Wide-field fundus photograph of an infant
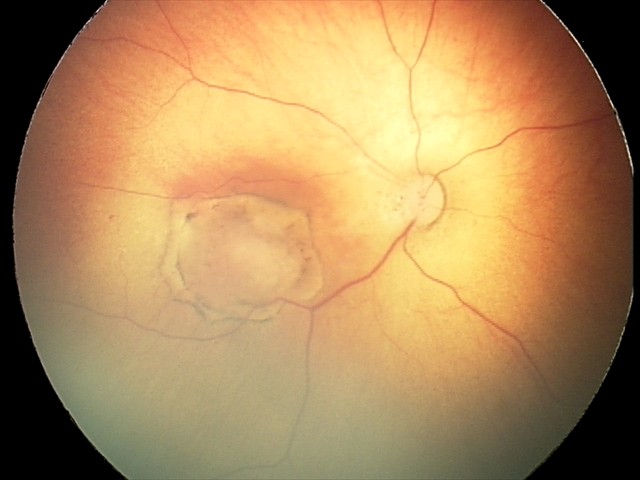 Q: What was the screening finding?
A: toxoplasmosis chorioretinitis